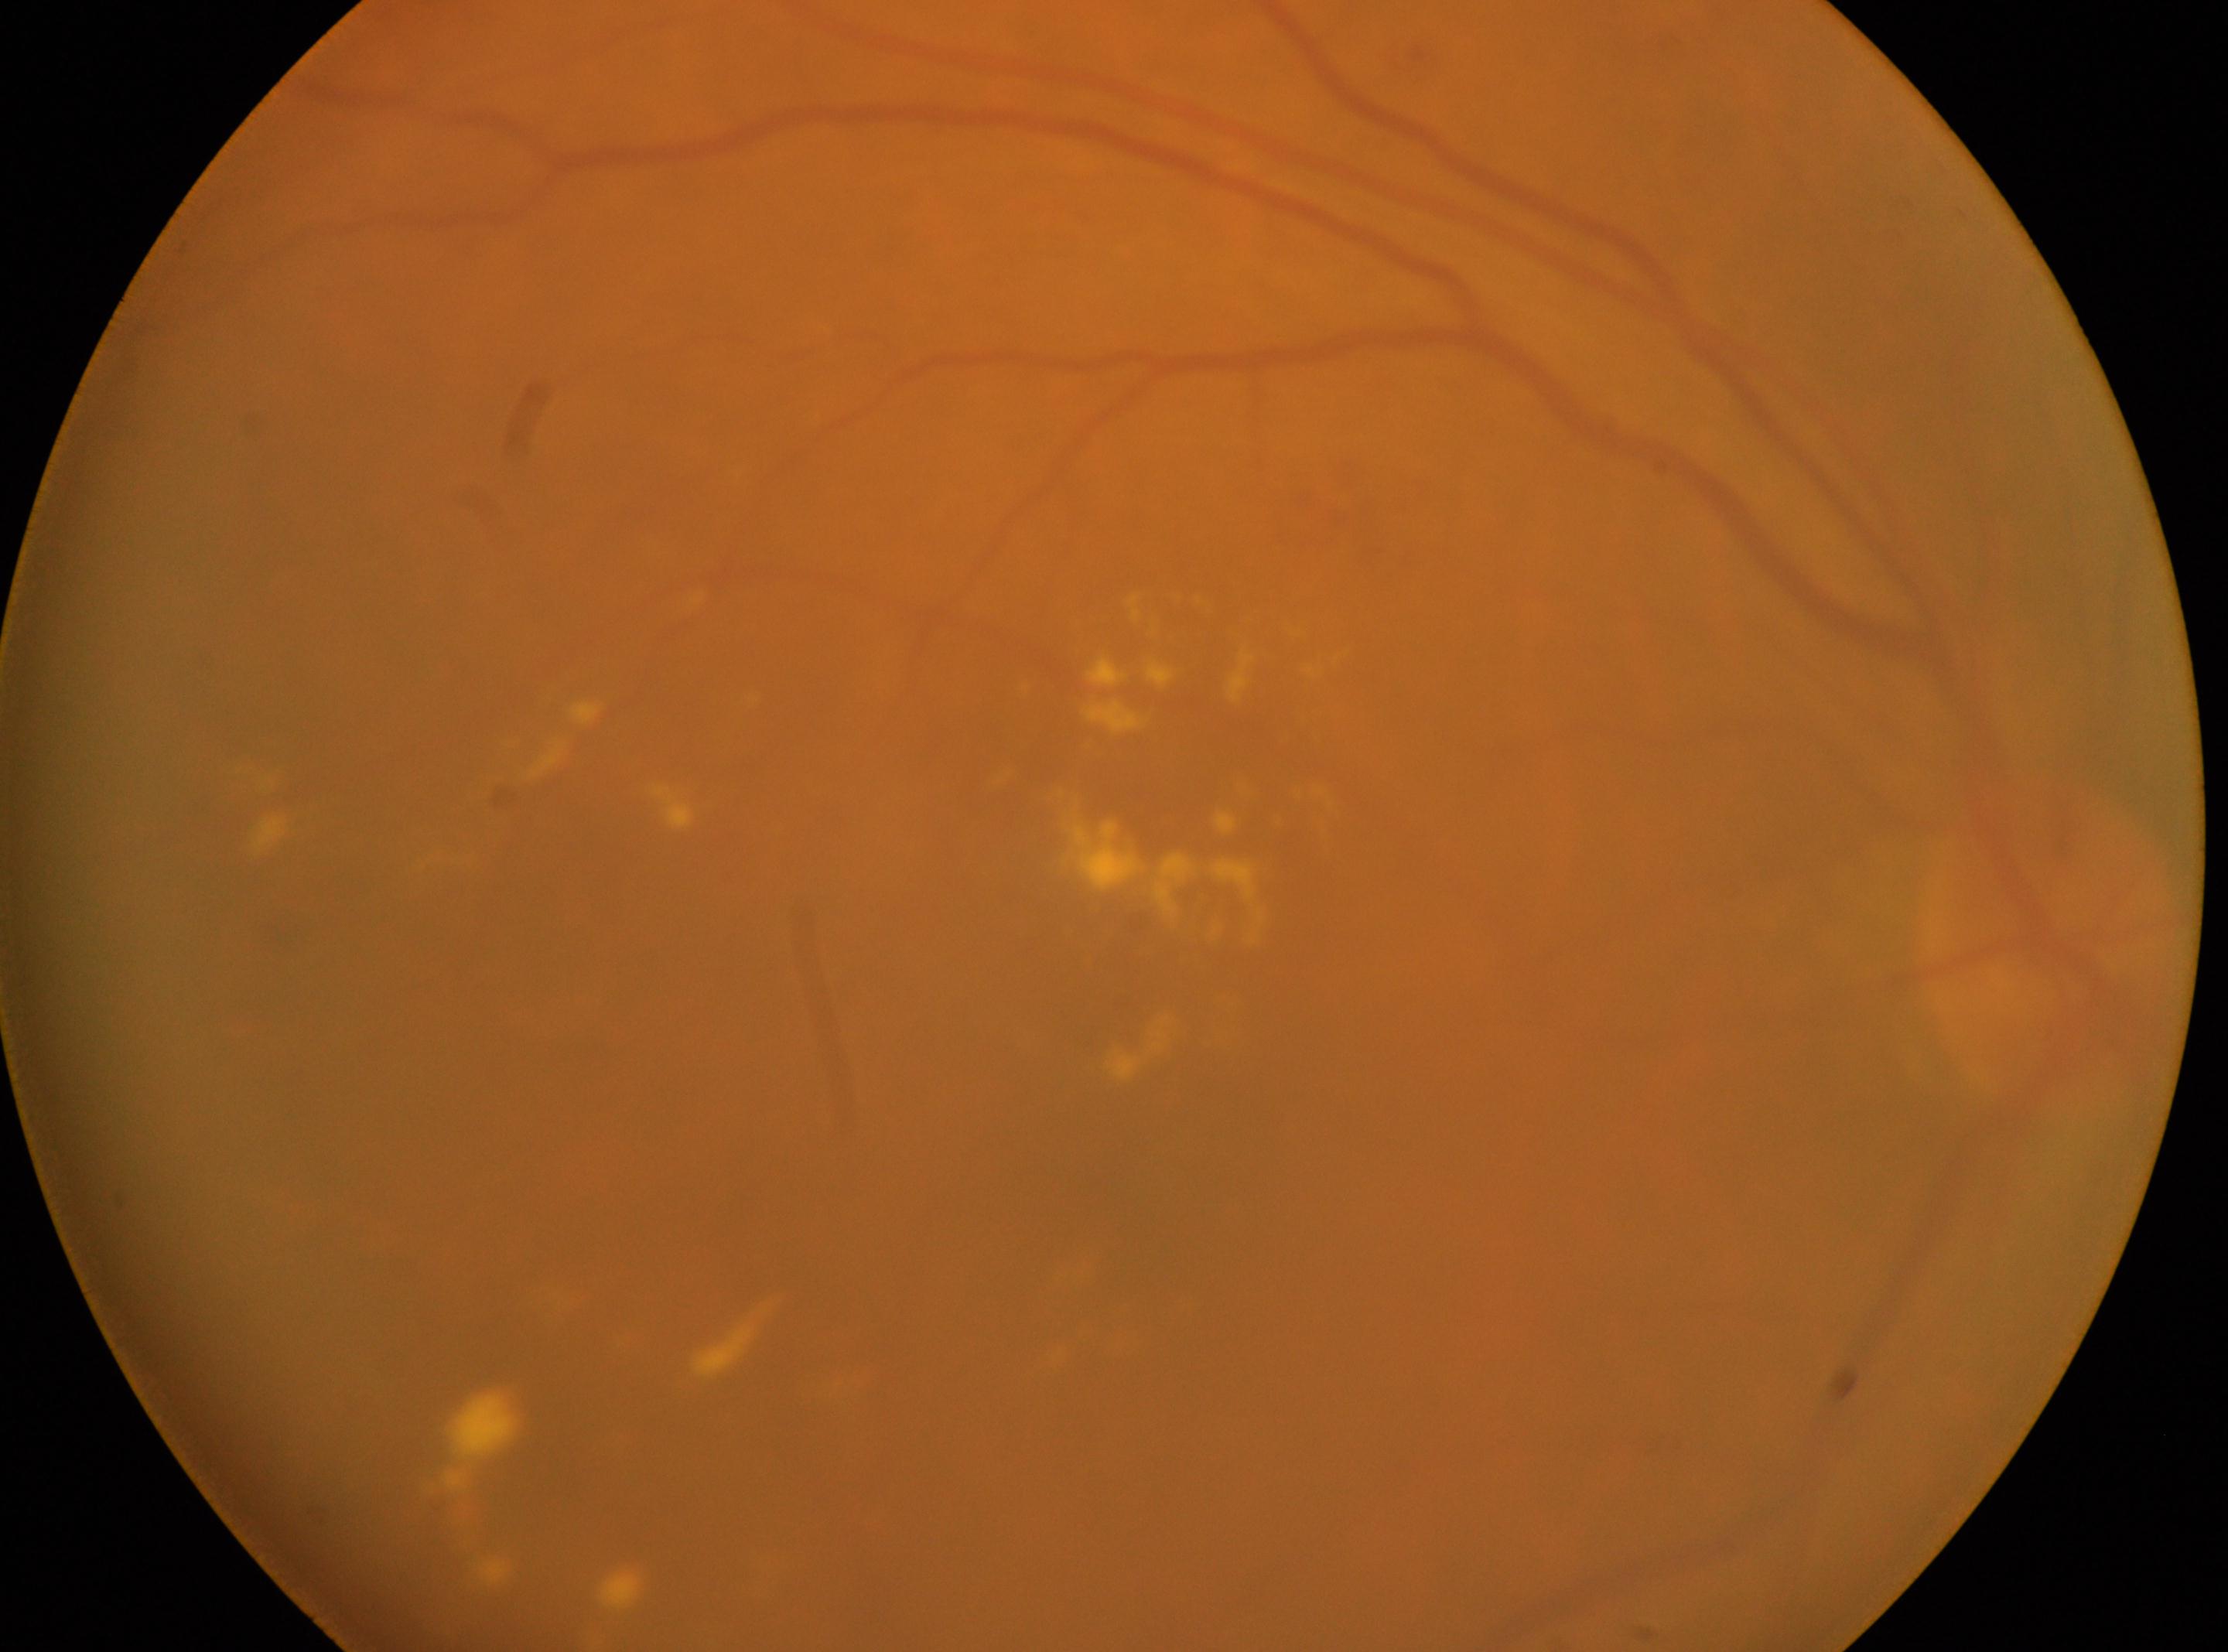
DR stage: grade 2 (moderate NPDR). The image shows the right eye. The macula center is at x=1156, y=1194. The retinopathy is classified as non-proliferative diabetic retinopathy. Optic disc located at x=2045, y=943.